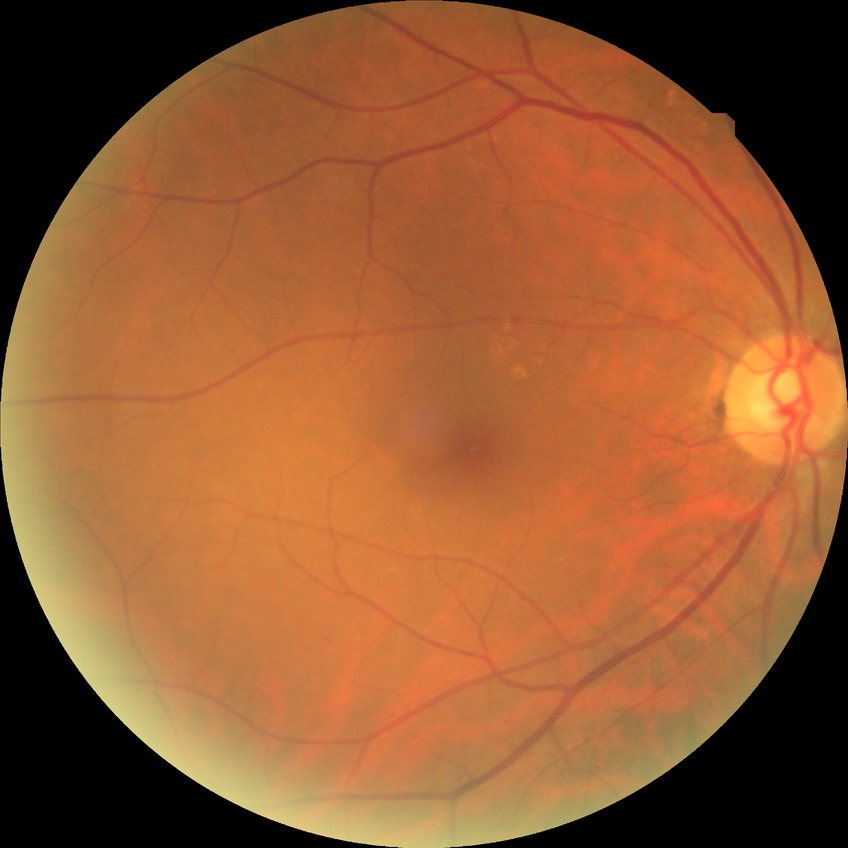
retinopathy stage: no diabetic retinopathy.